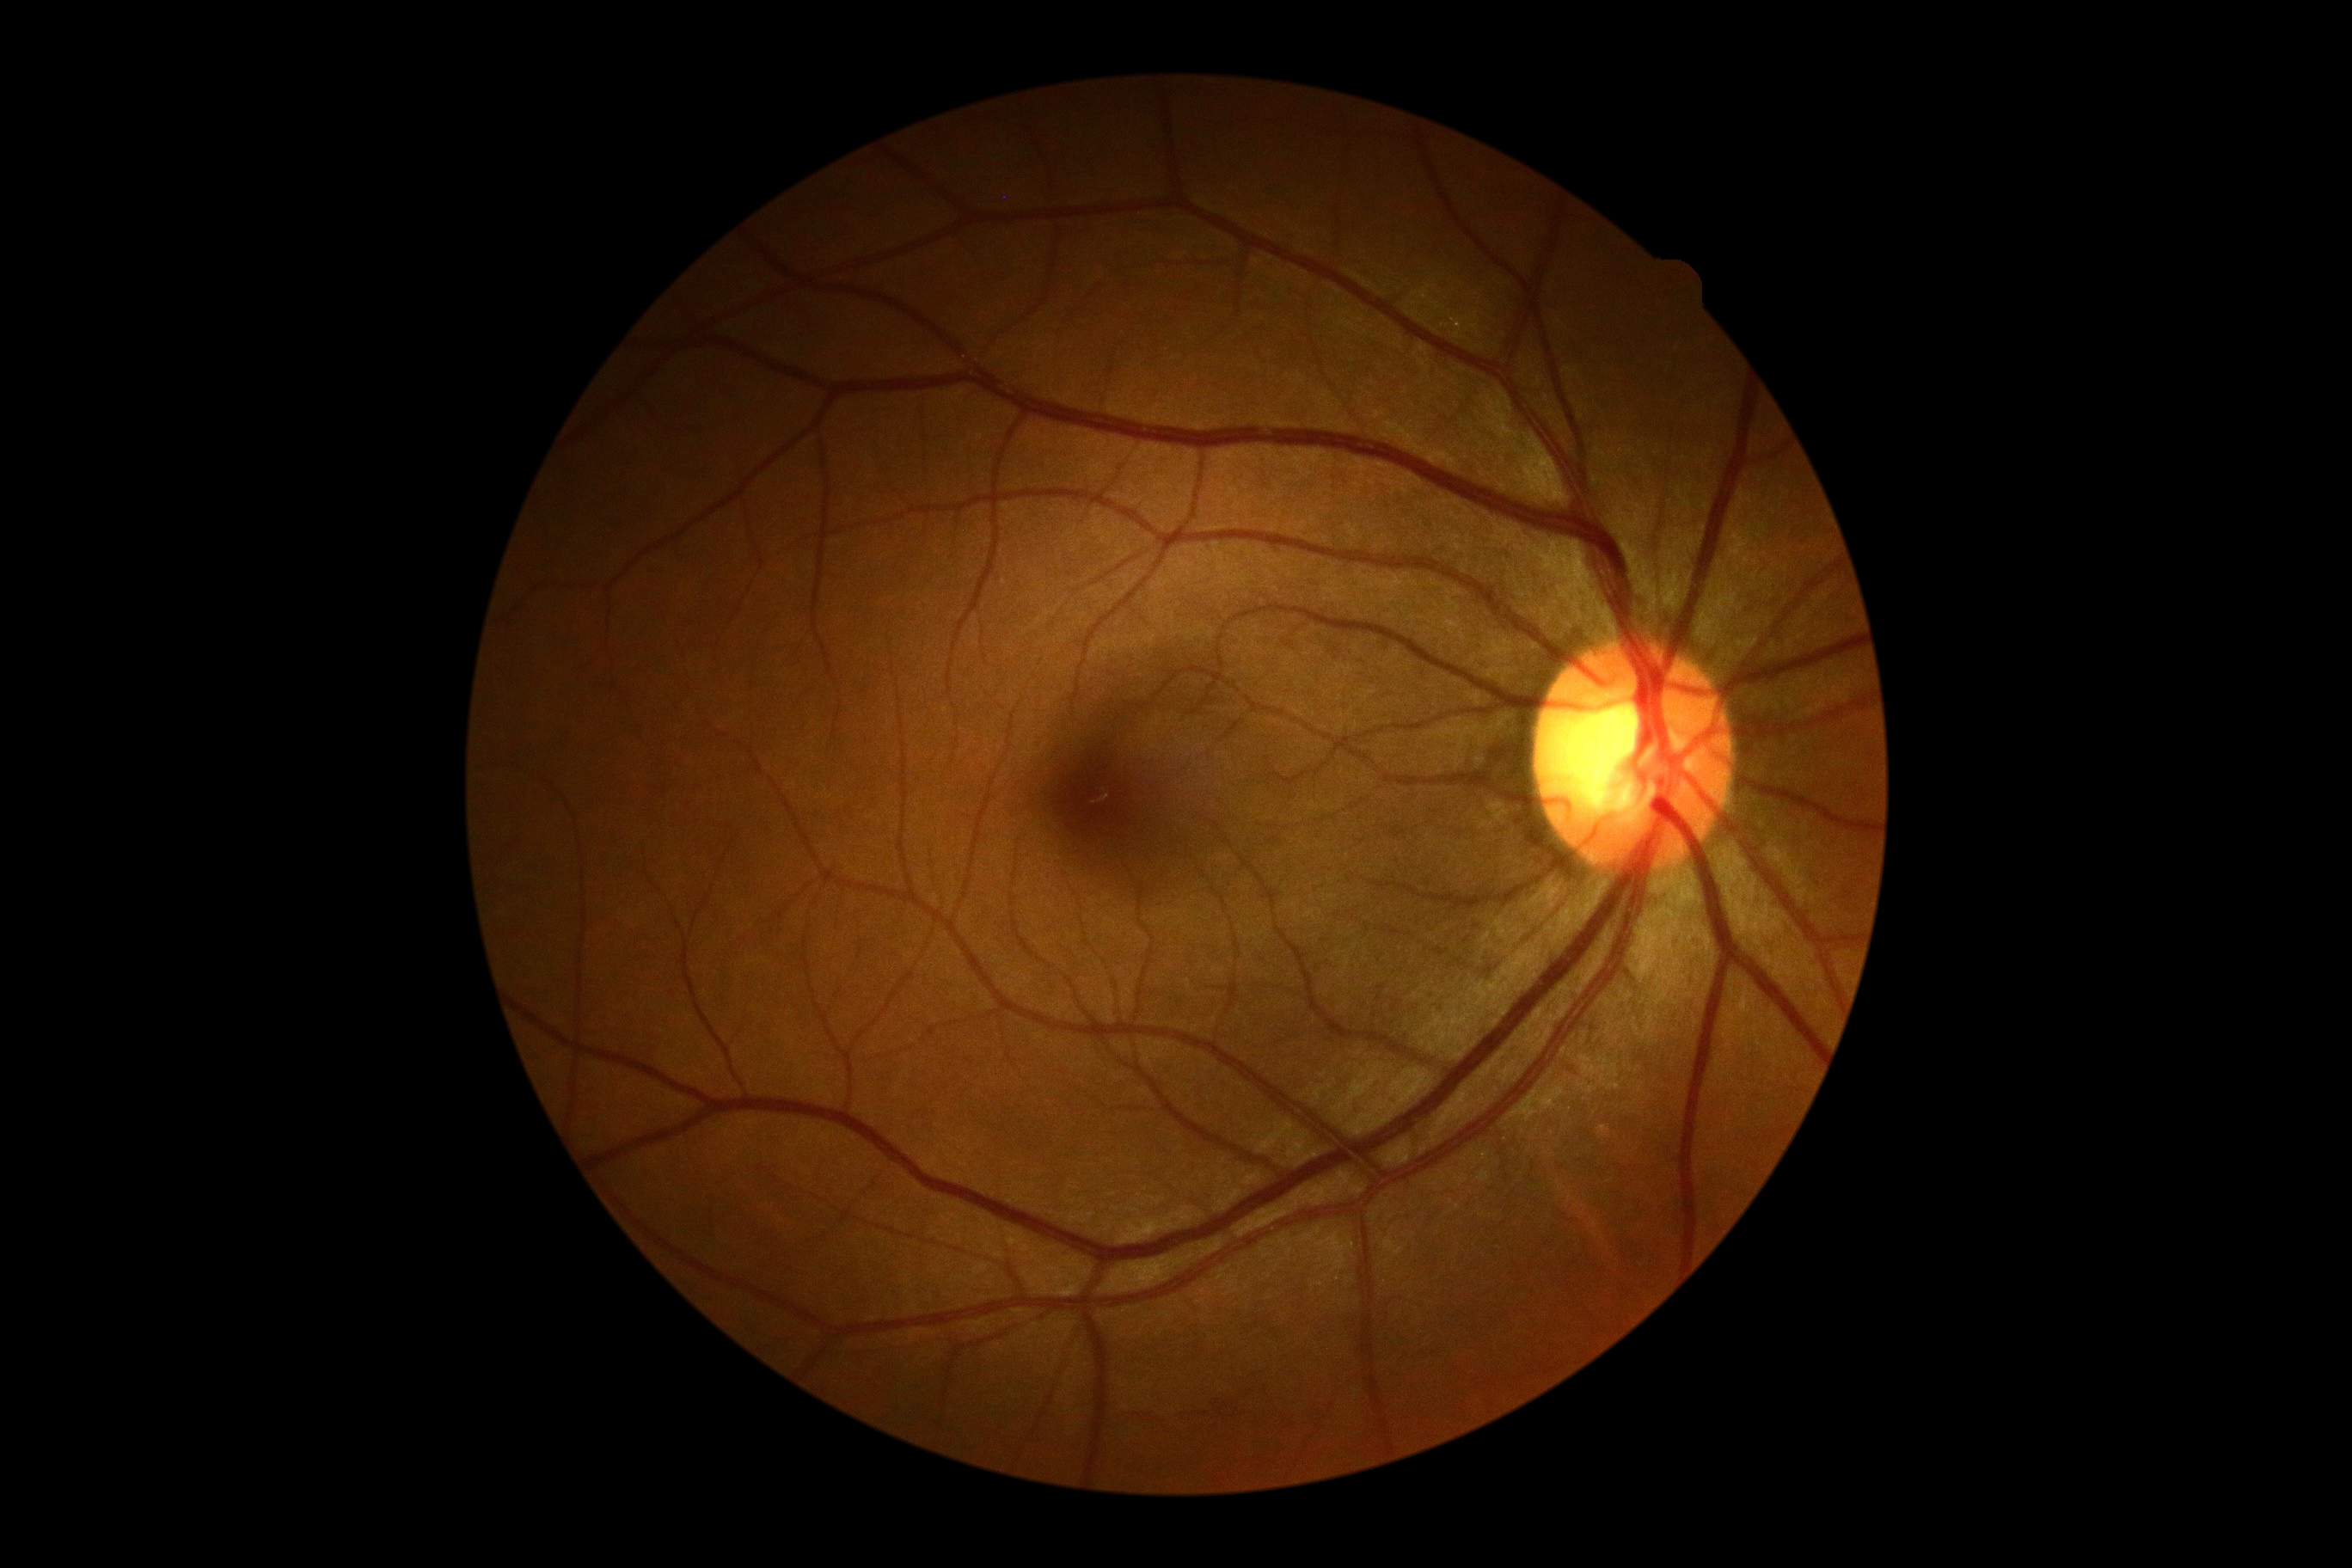 DR: 0/4.